512x512px: 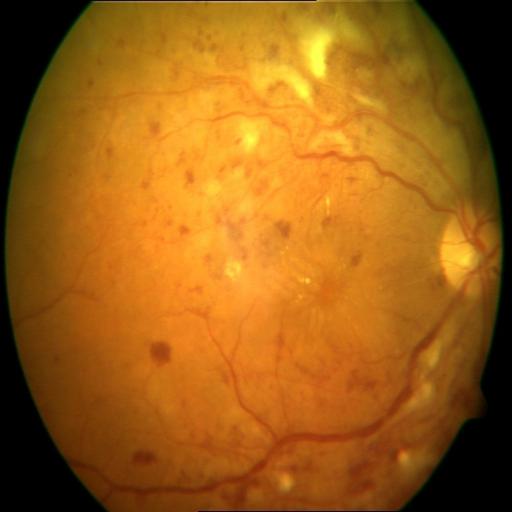

Impression: central retinal vein occlusion | hemorrhagic retinopathy.